Nonmydriatic fundus photograph, 848 by 848 pixels, CFP, modified Davis classification, NIDEK AFC-230 fundus camera, 45° field of view
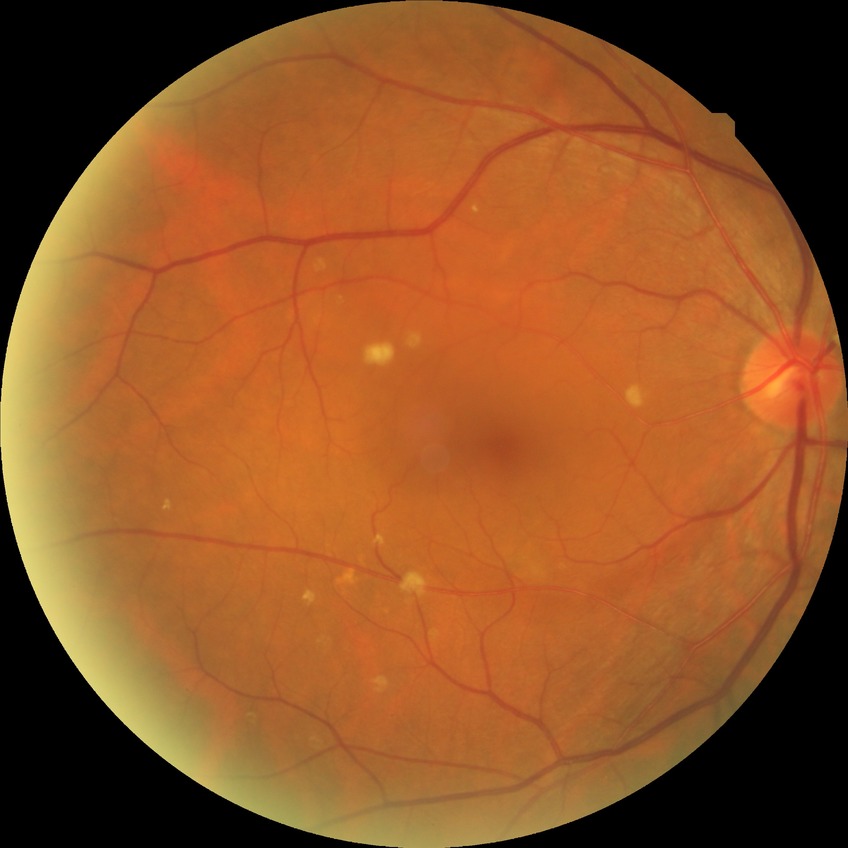

diabetic retinopathy (DR): no diabetic retinopathy (NDR)